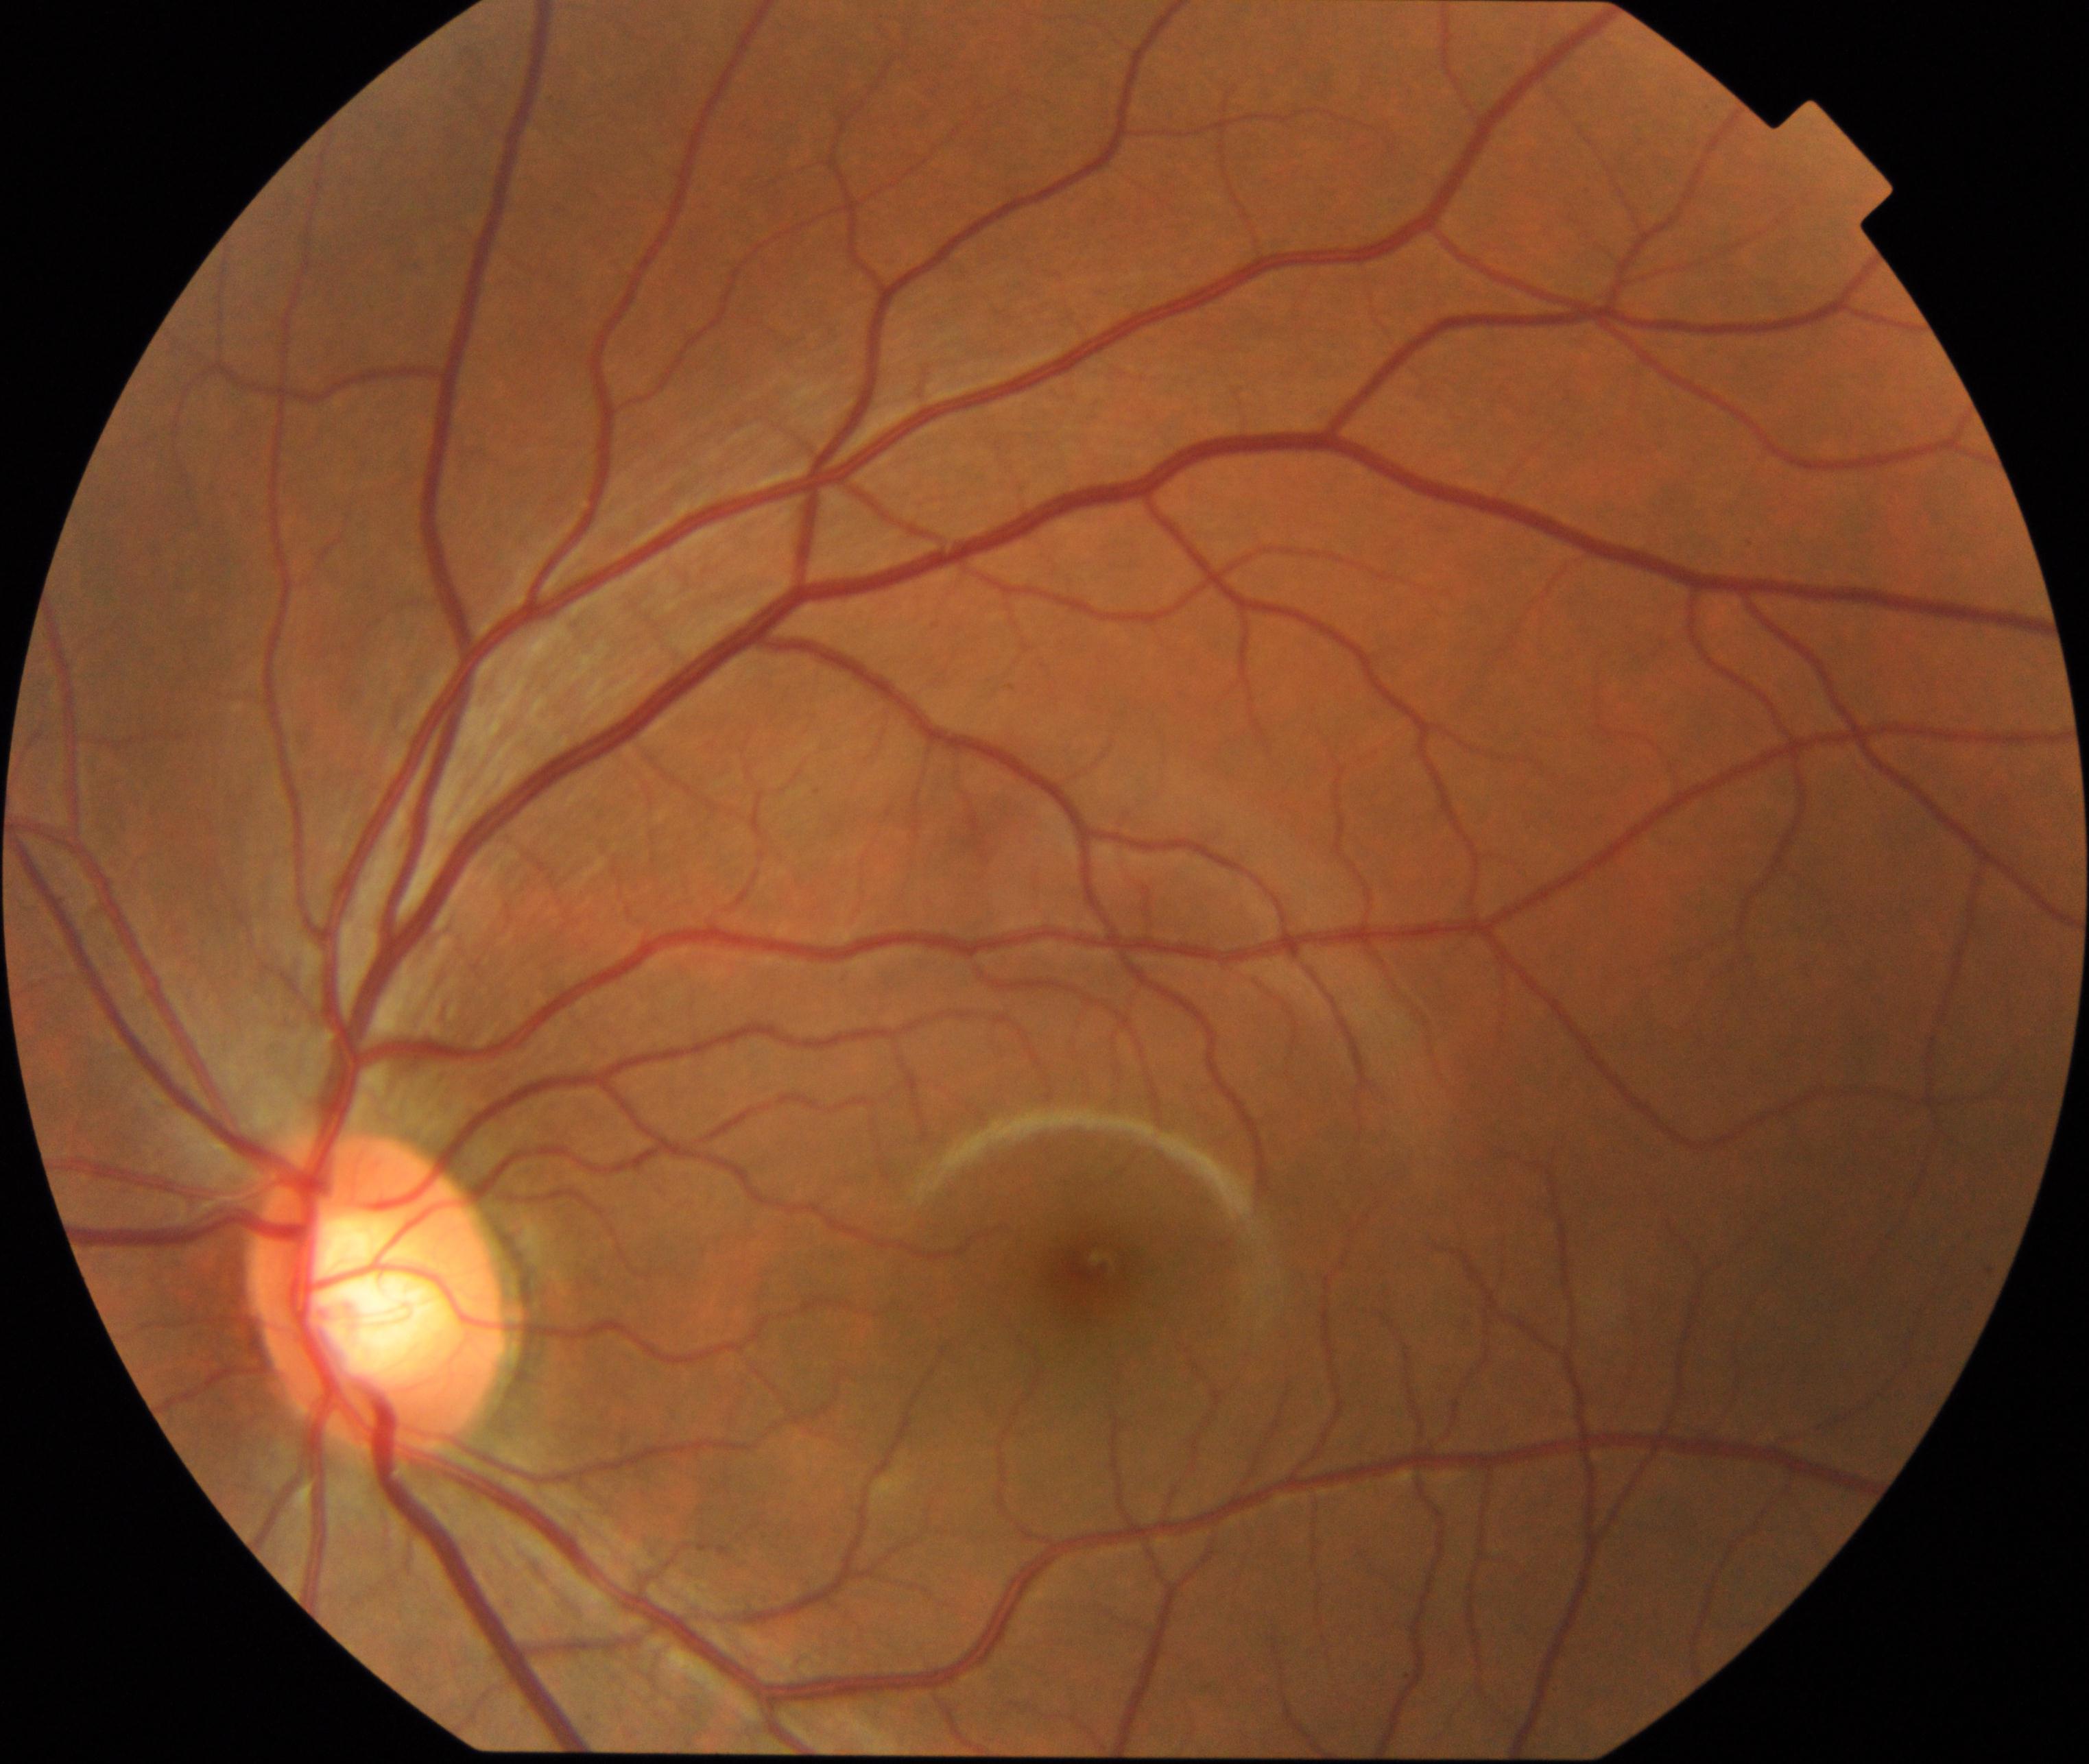 Findings: large optic cup.